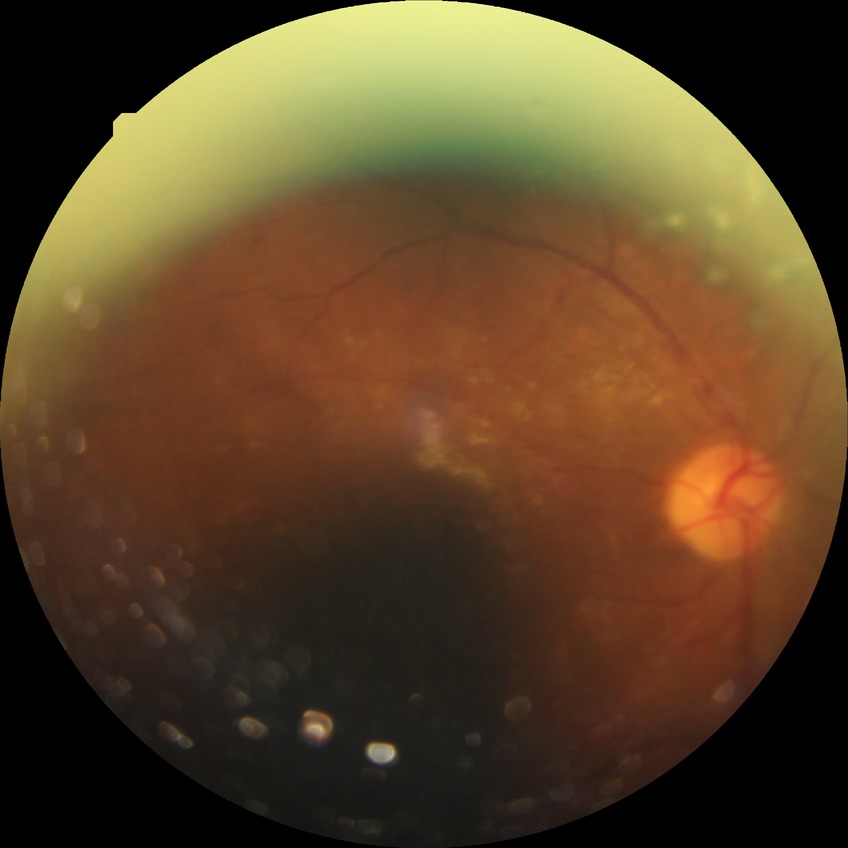
Diabetic retinopathy (DR): proliferative diabetic retinopathy (PDR).